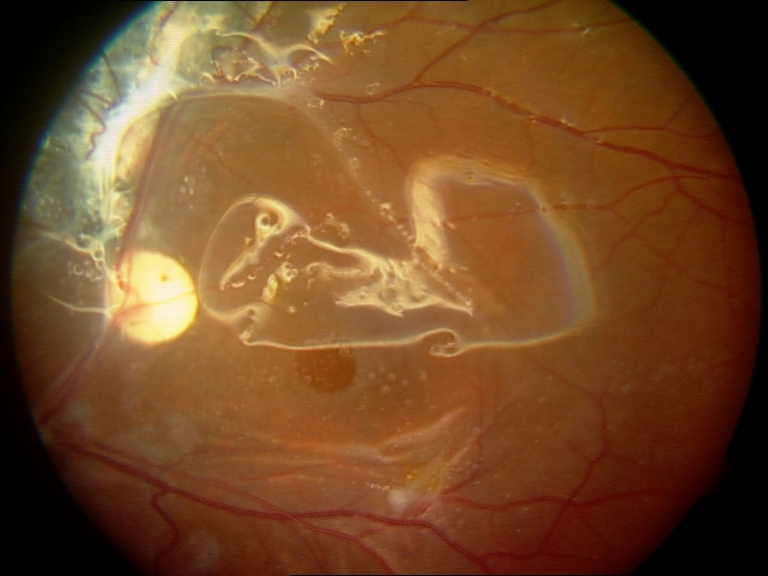
Silicone oil in the eye visible.